Modified Davis classification: 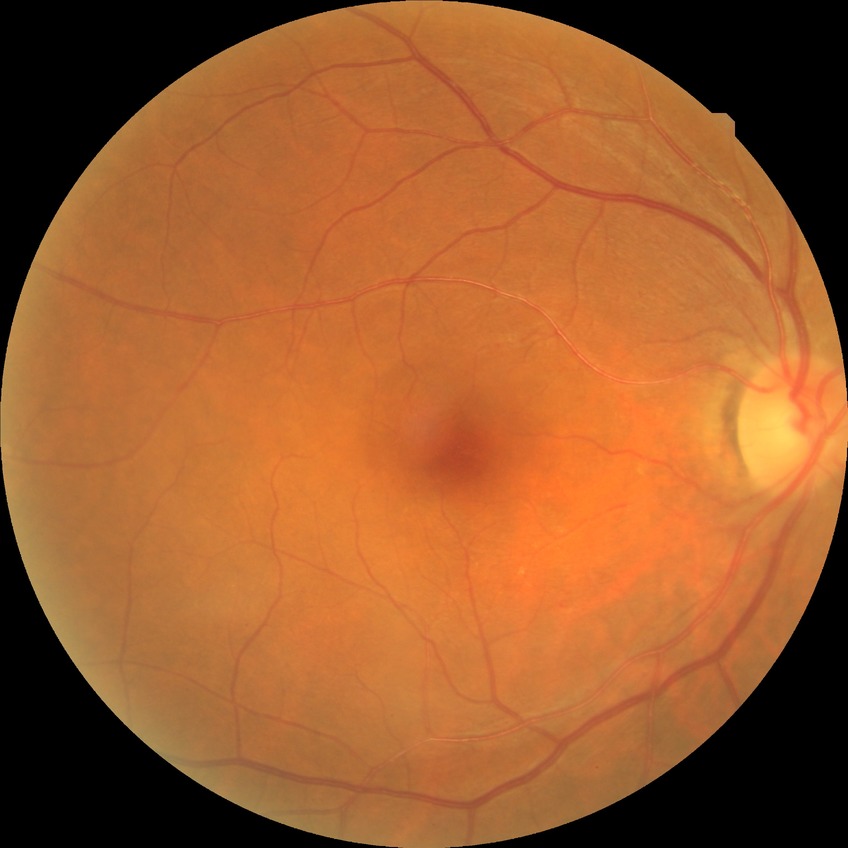 Diabetic retinopathy (DR) is NDR (no diabetic retinopathy).